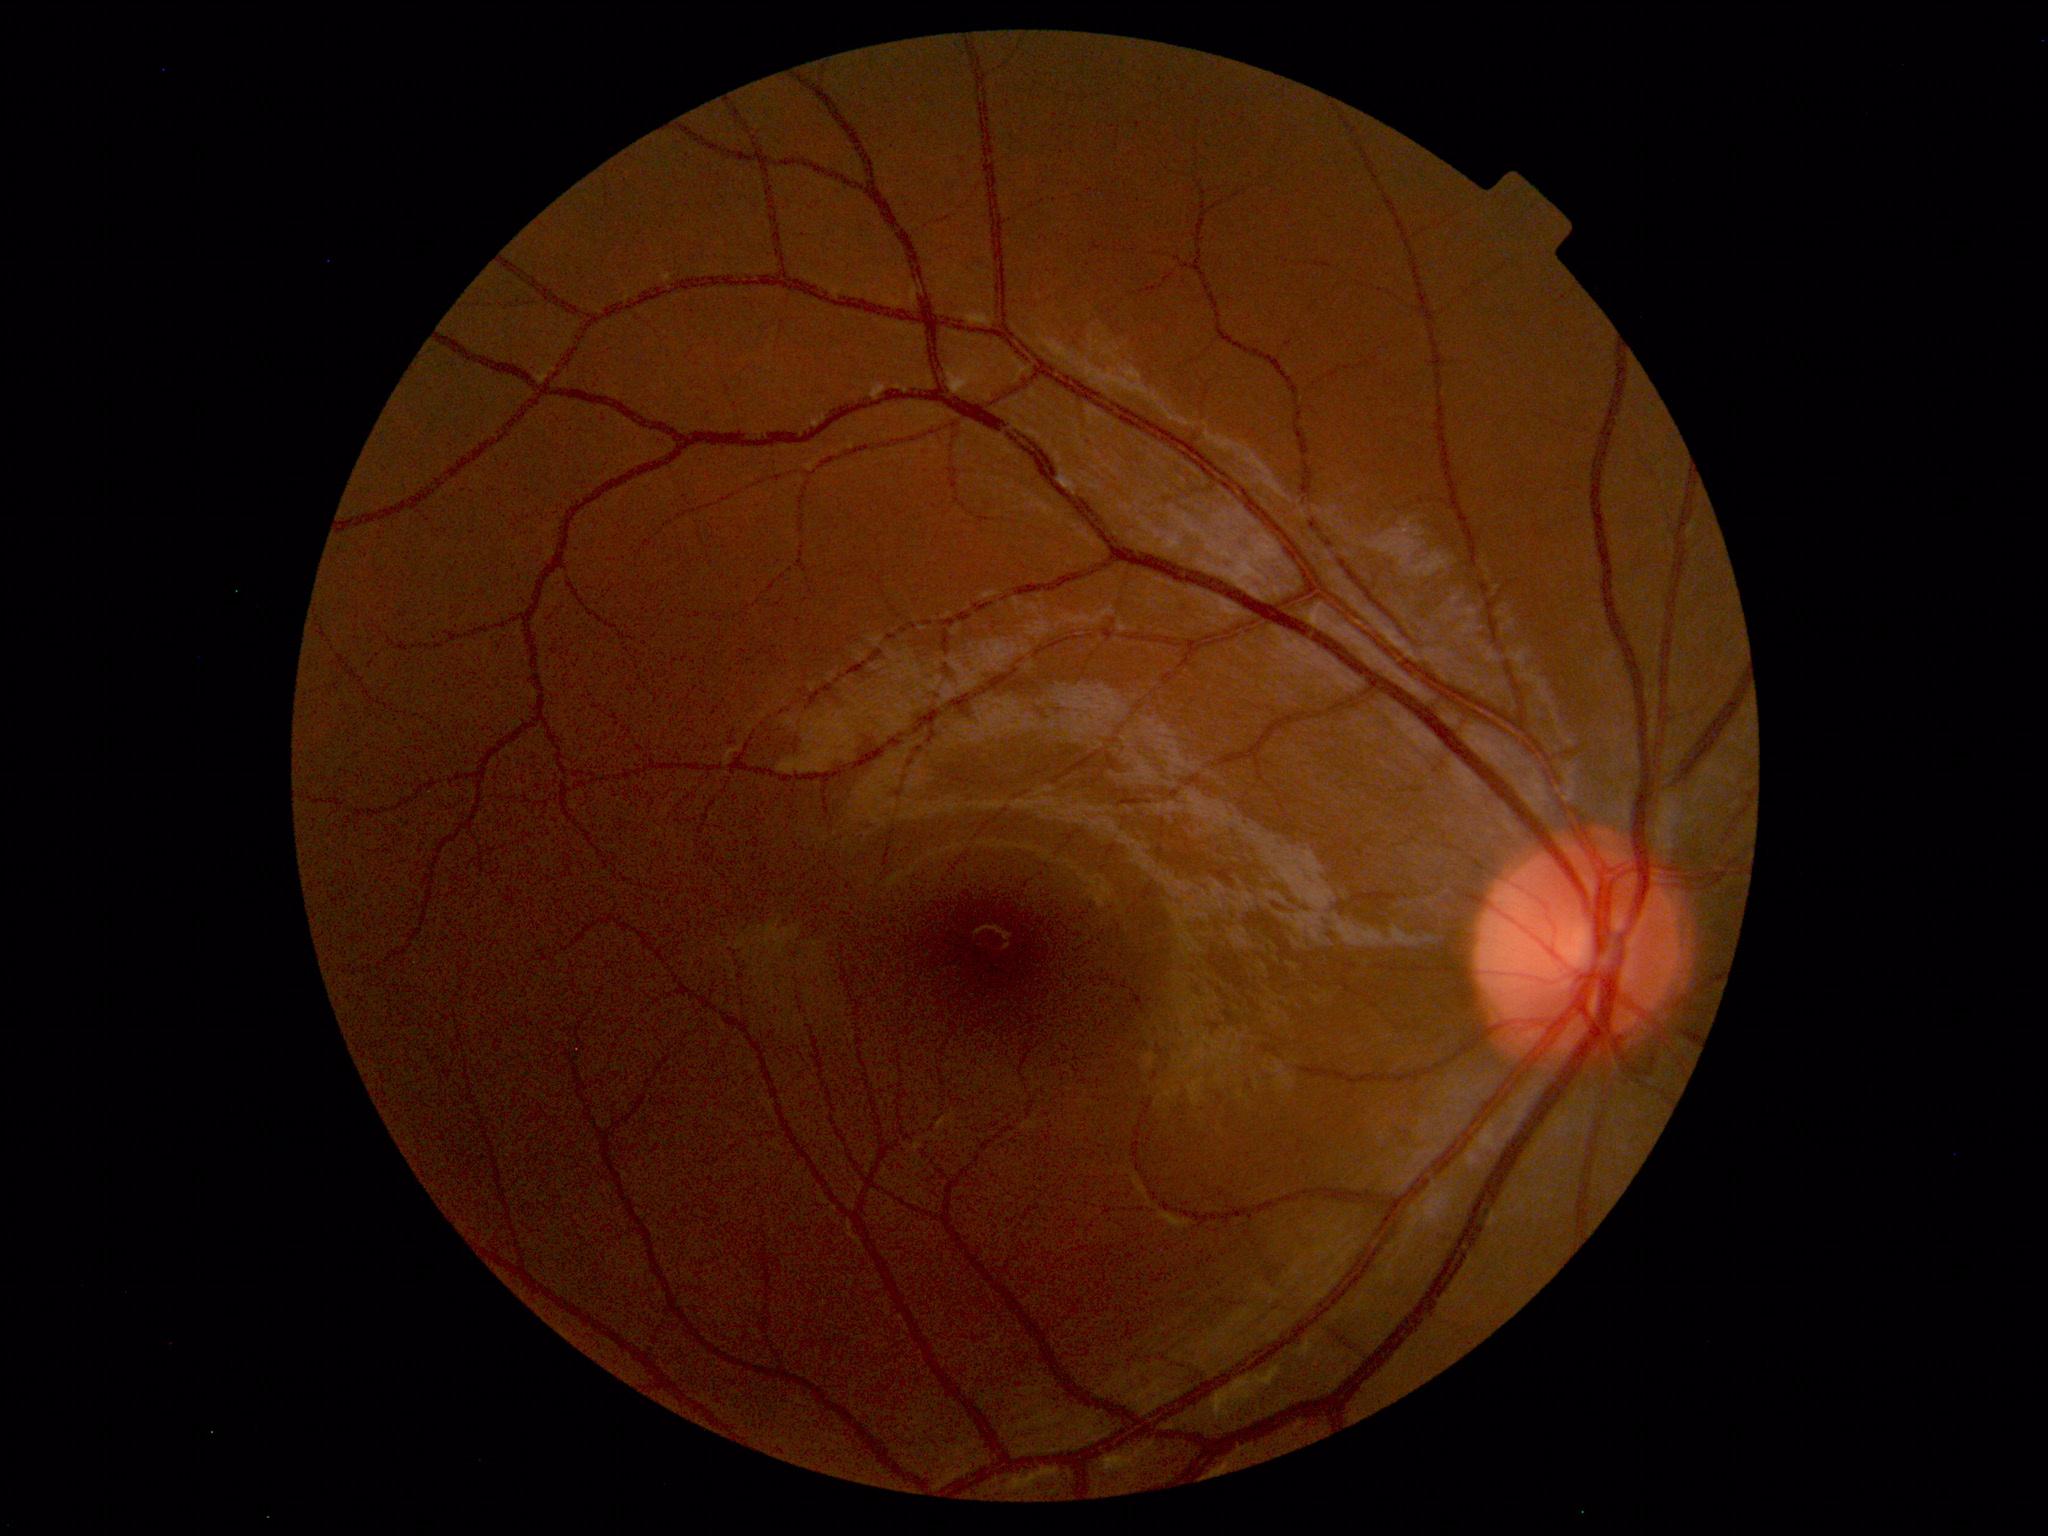 Normal fundus. No pathology identified.